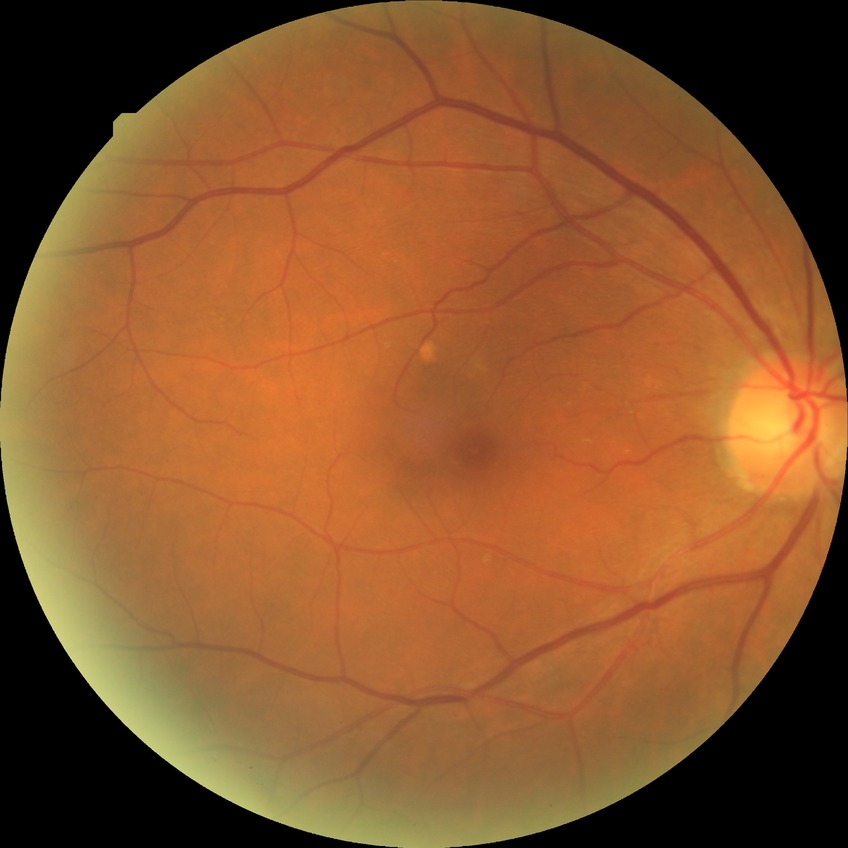
Diabetic retinopathy (DR) is no diabetic retinopathy (NDR).